Phoenix ICON wide-field infant fundus image.
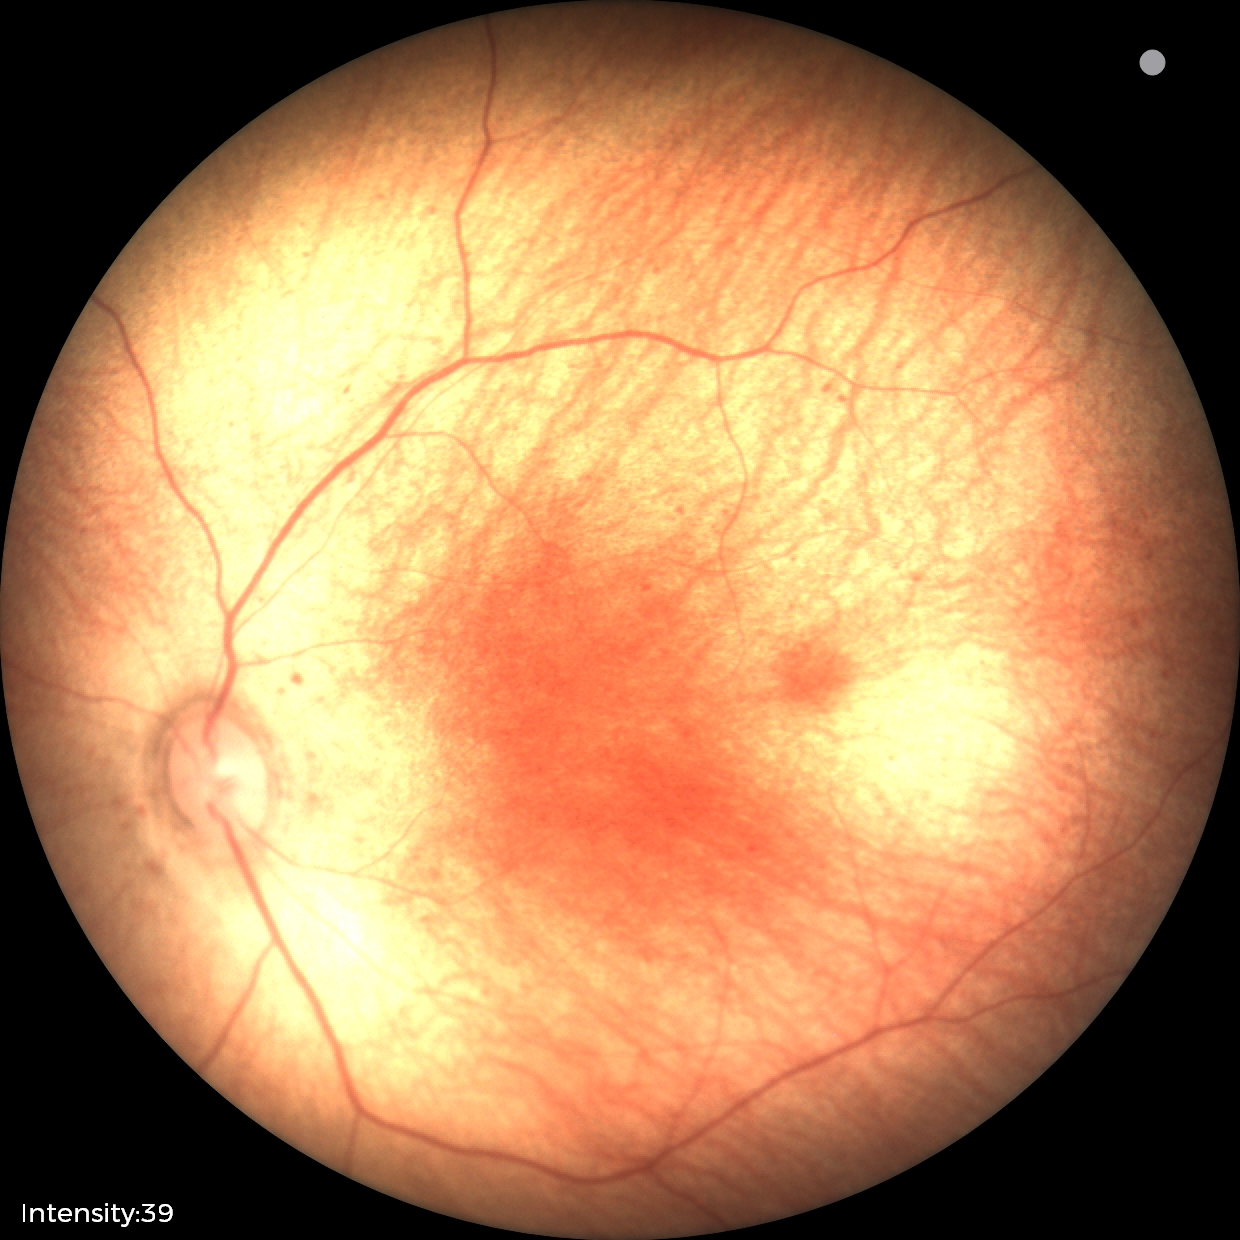

No retinal pathology identified on screening.